700 x 700 pixels; Topcon TRC retinal camera, IMAGEnet capture system; disc-centered fundus crop:
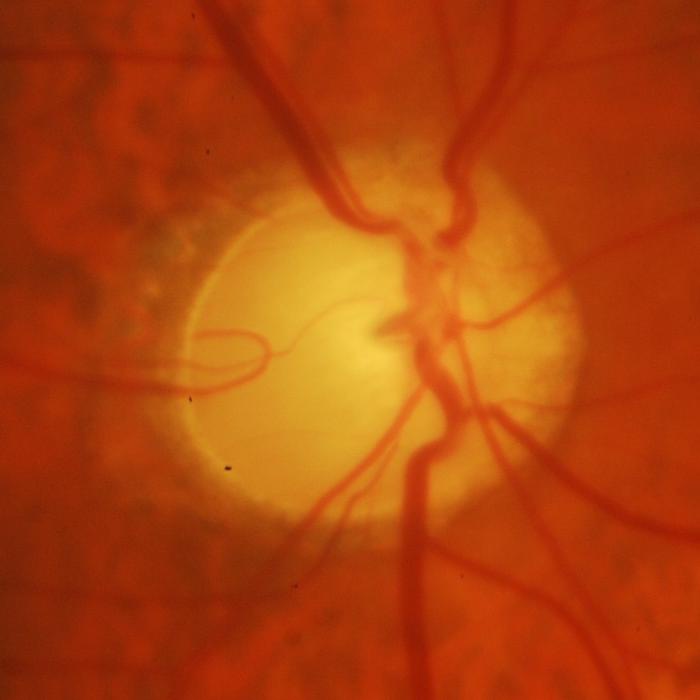

Q: Is glaucoma present?
A: Yes — glaucomatous changes.